Pediatric retinal photograph (wide-field): 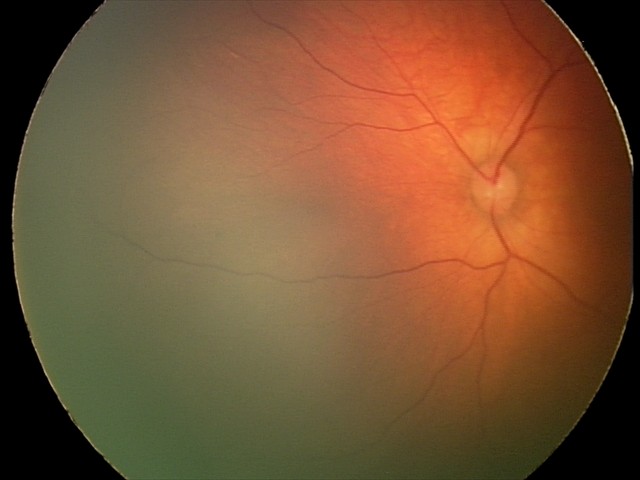

Diagnosis = retinal hemorrhages.